Remidio smartphone fundus camera, color fundus photograph, 1659 x 2212 pixels — 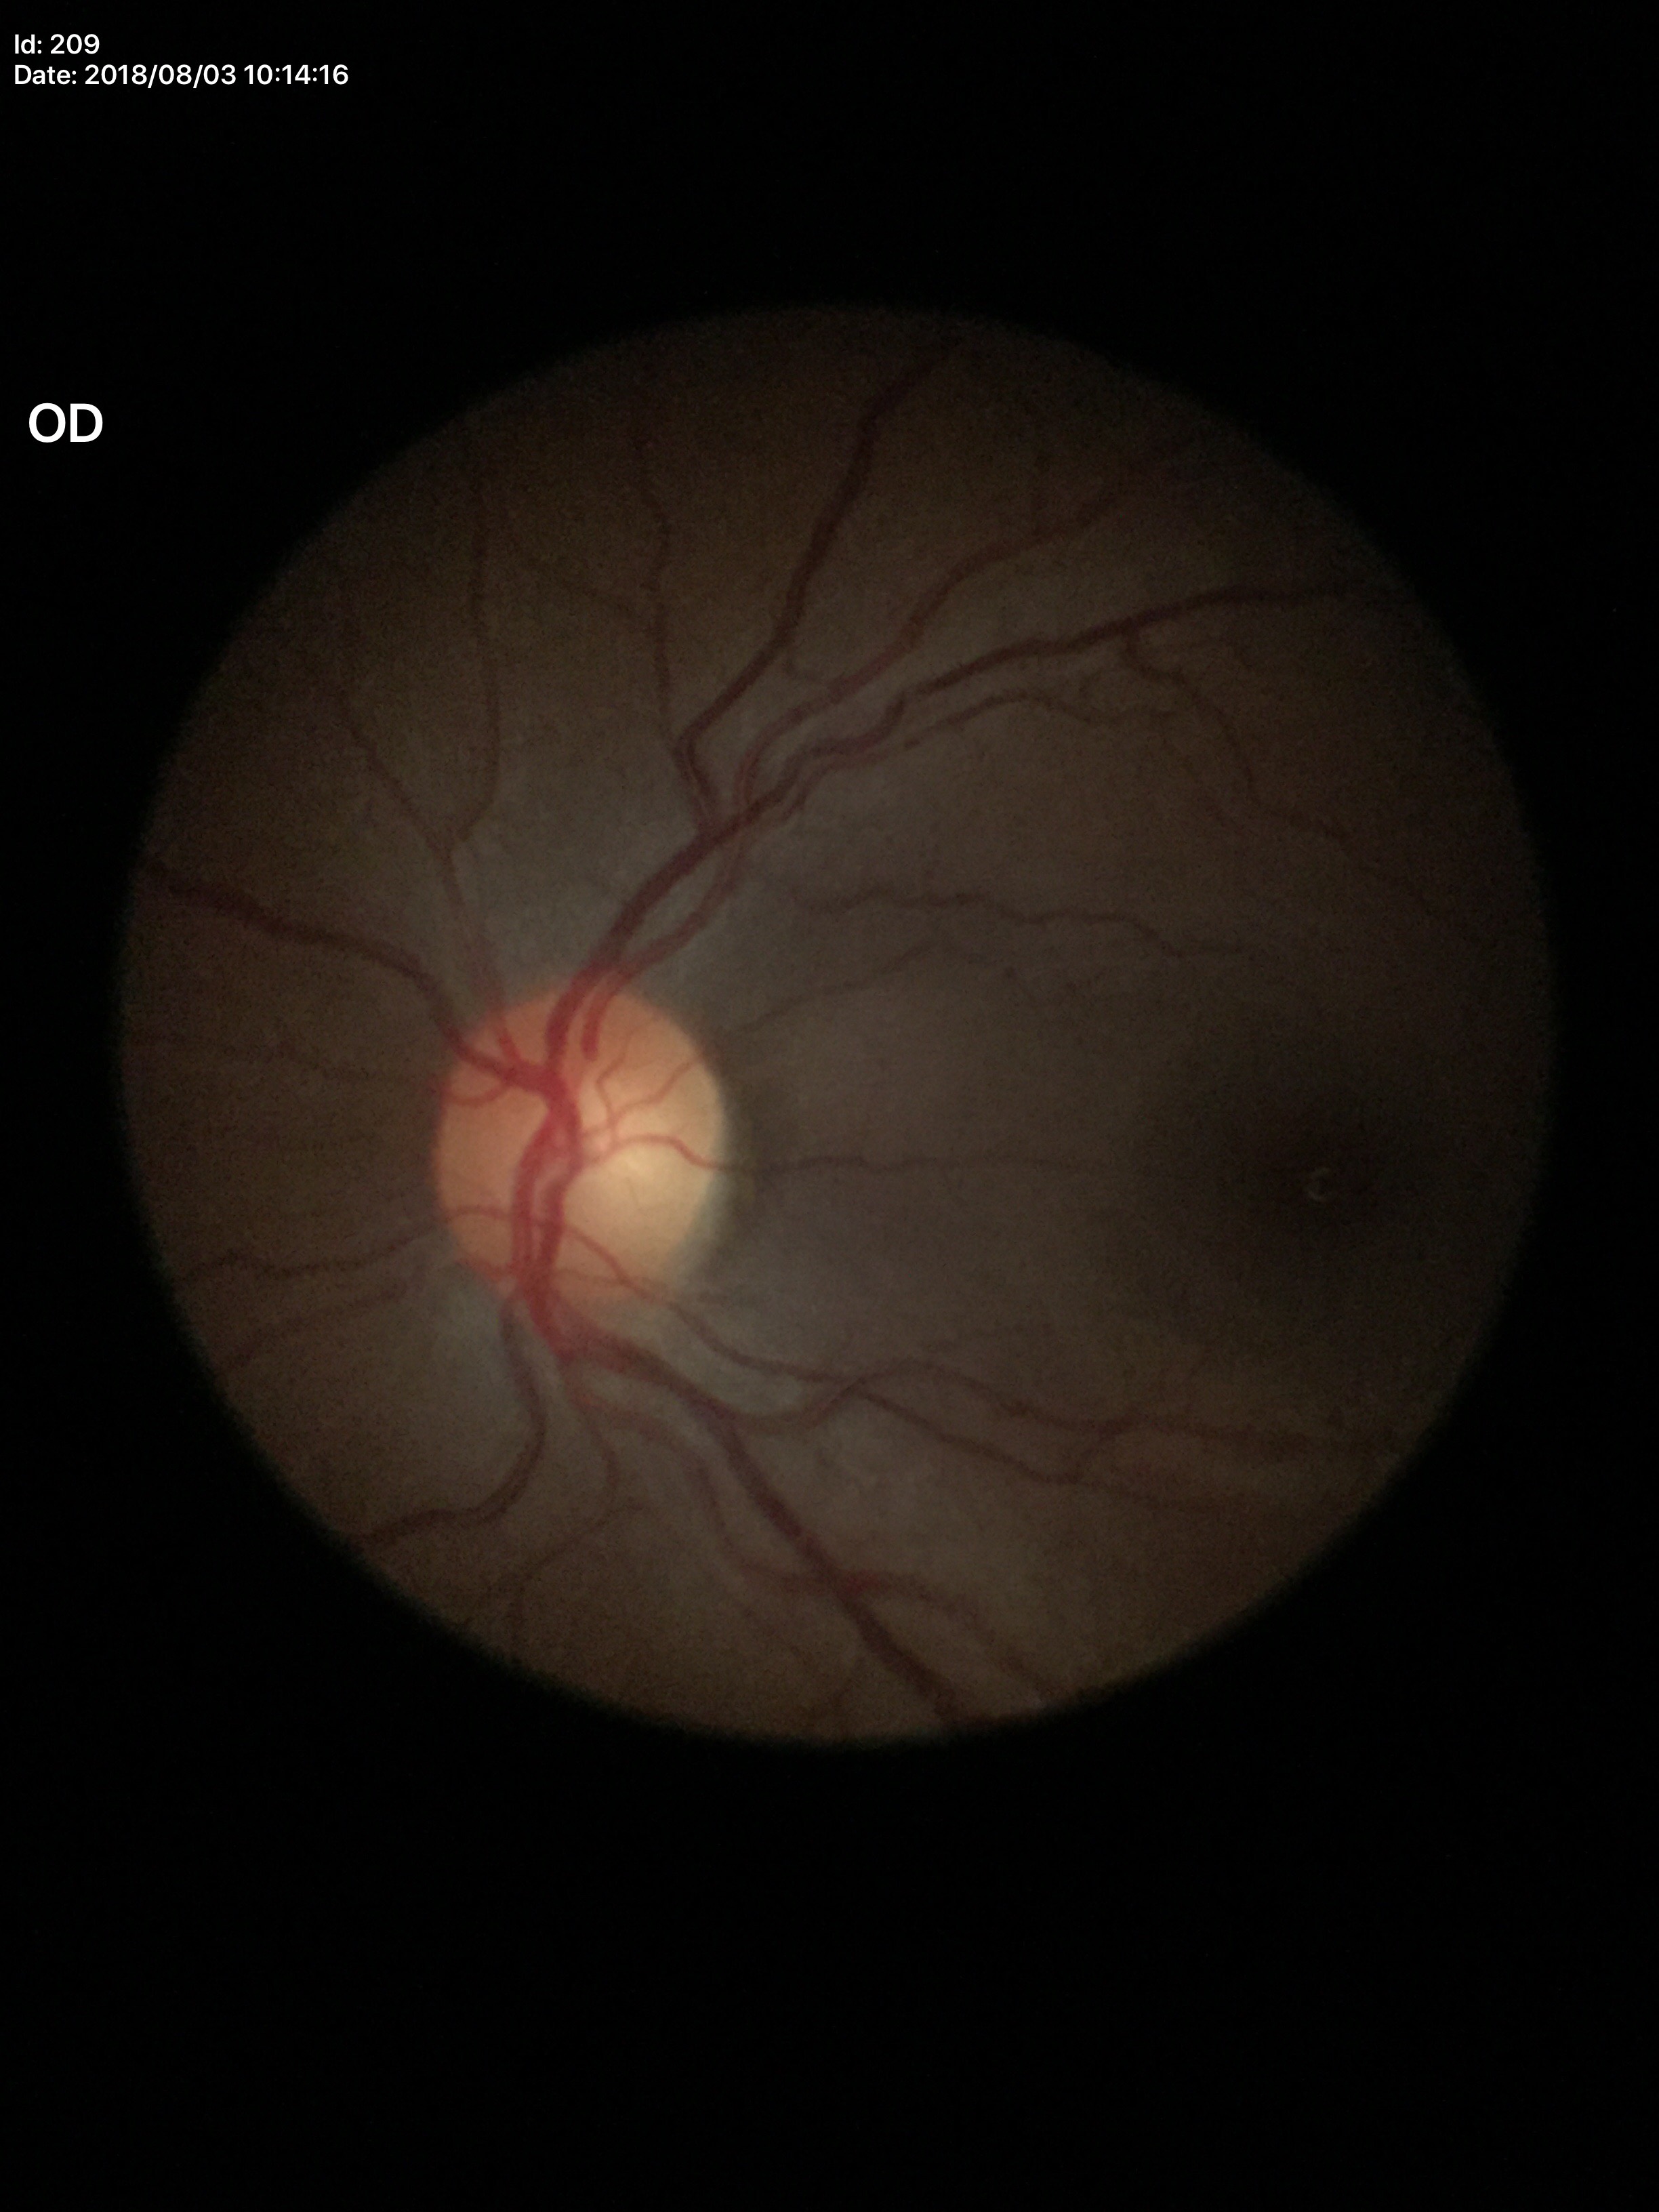

Glaucoma decision: not suspect (all 5 graders called normal). Vertical C/D ratio (VCDR): 0.47. Horizontal cup-disc ratio (HCDR) is 0.47.